CFP; nonmydriatic — 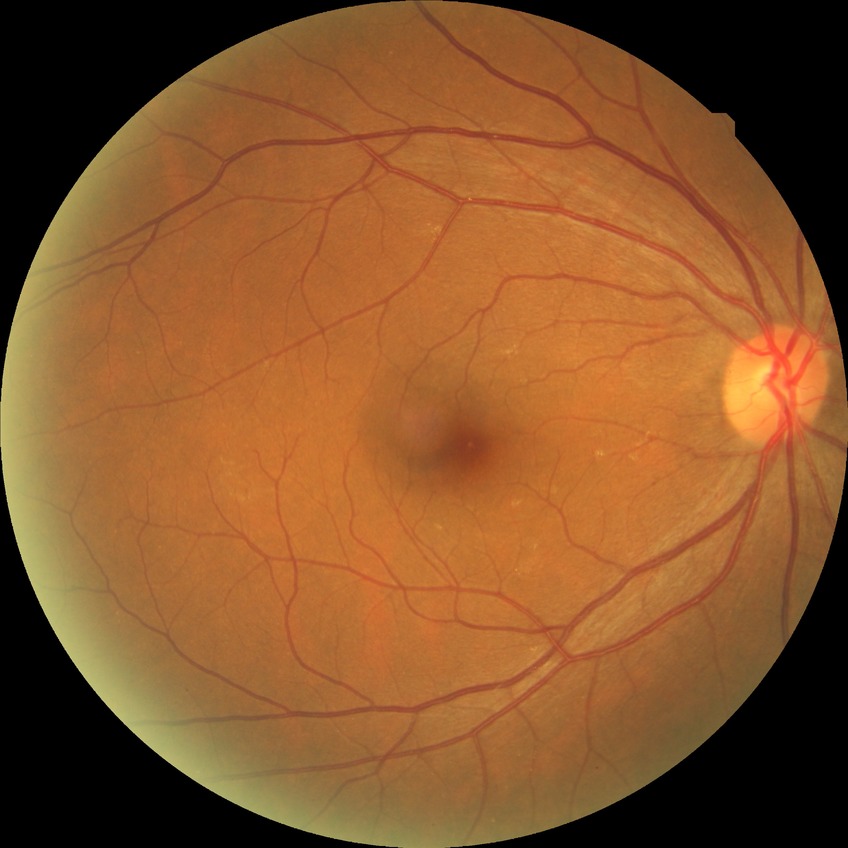
Modified Davis classification is no diabetic retinopathy.